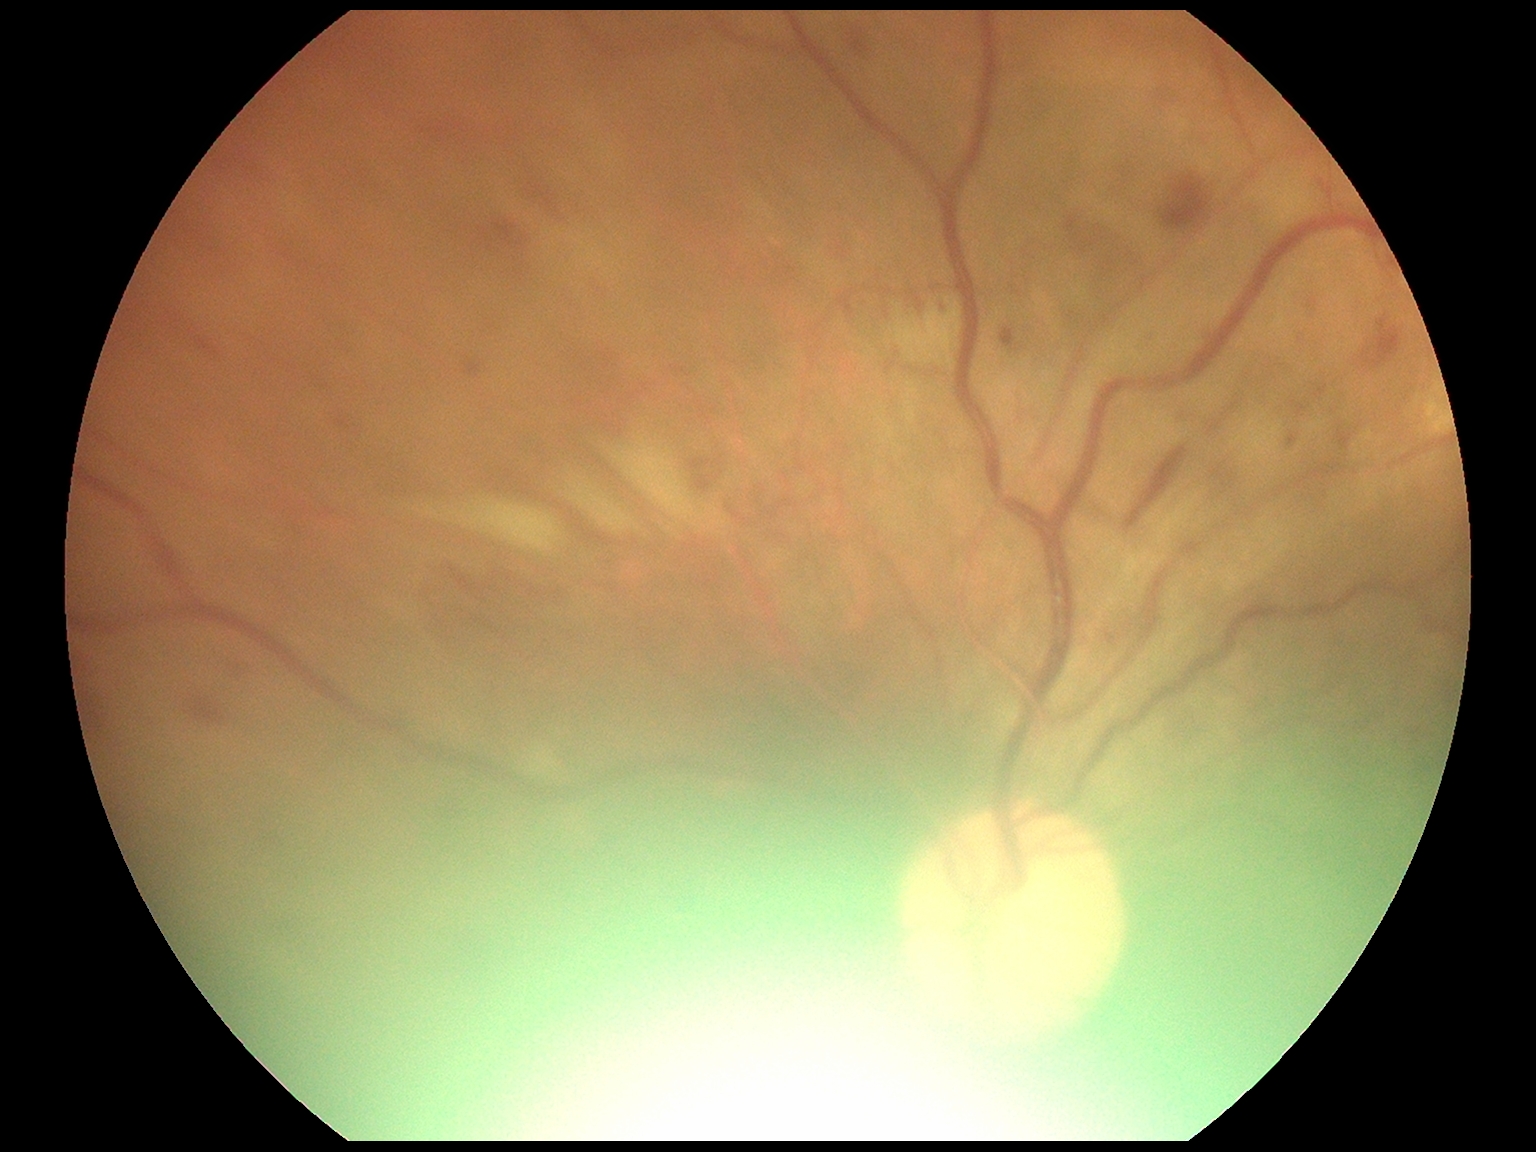 {
  "dr_grade": "2 (moderate NPDR)"
}